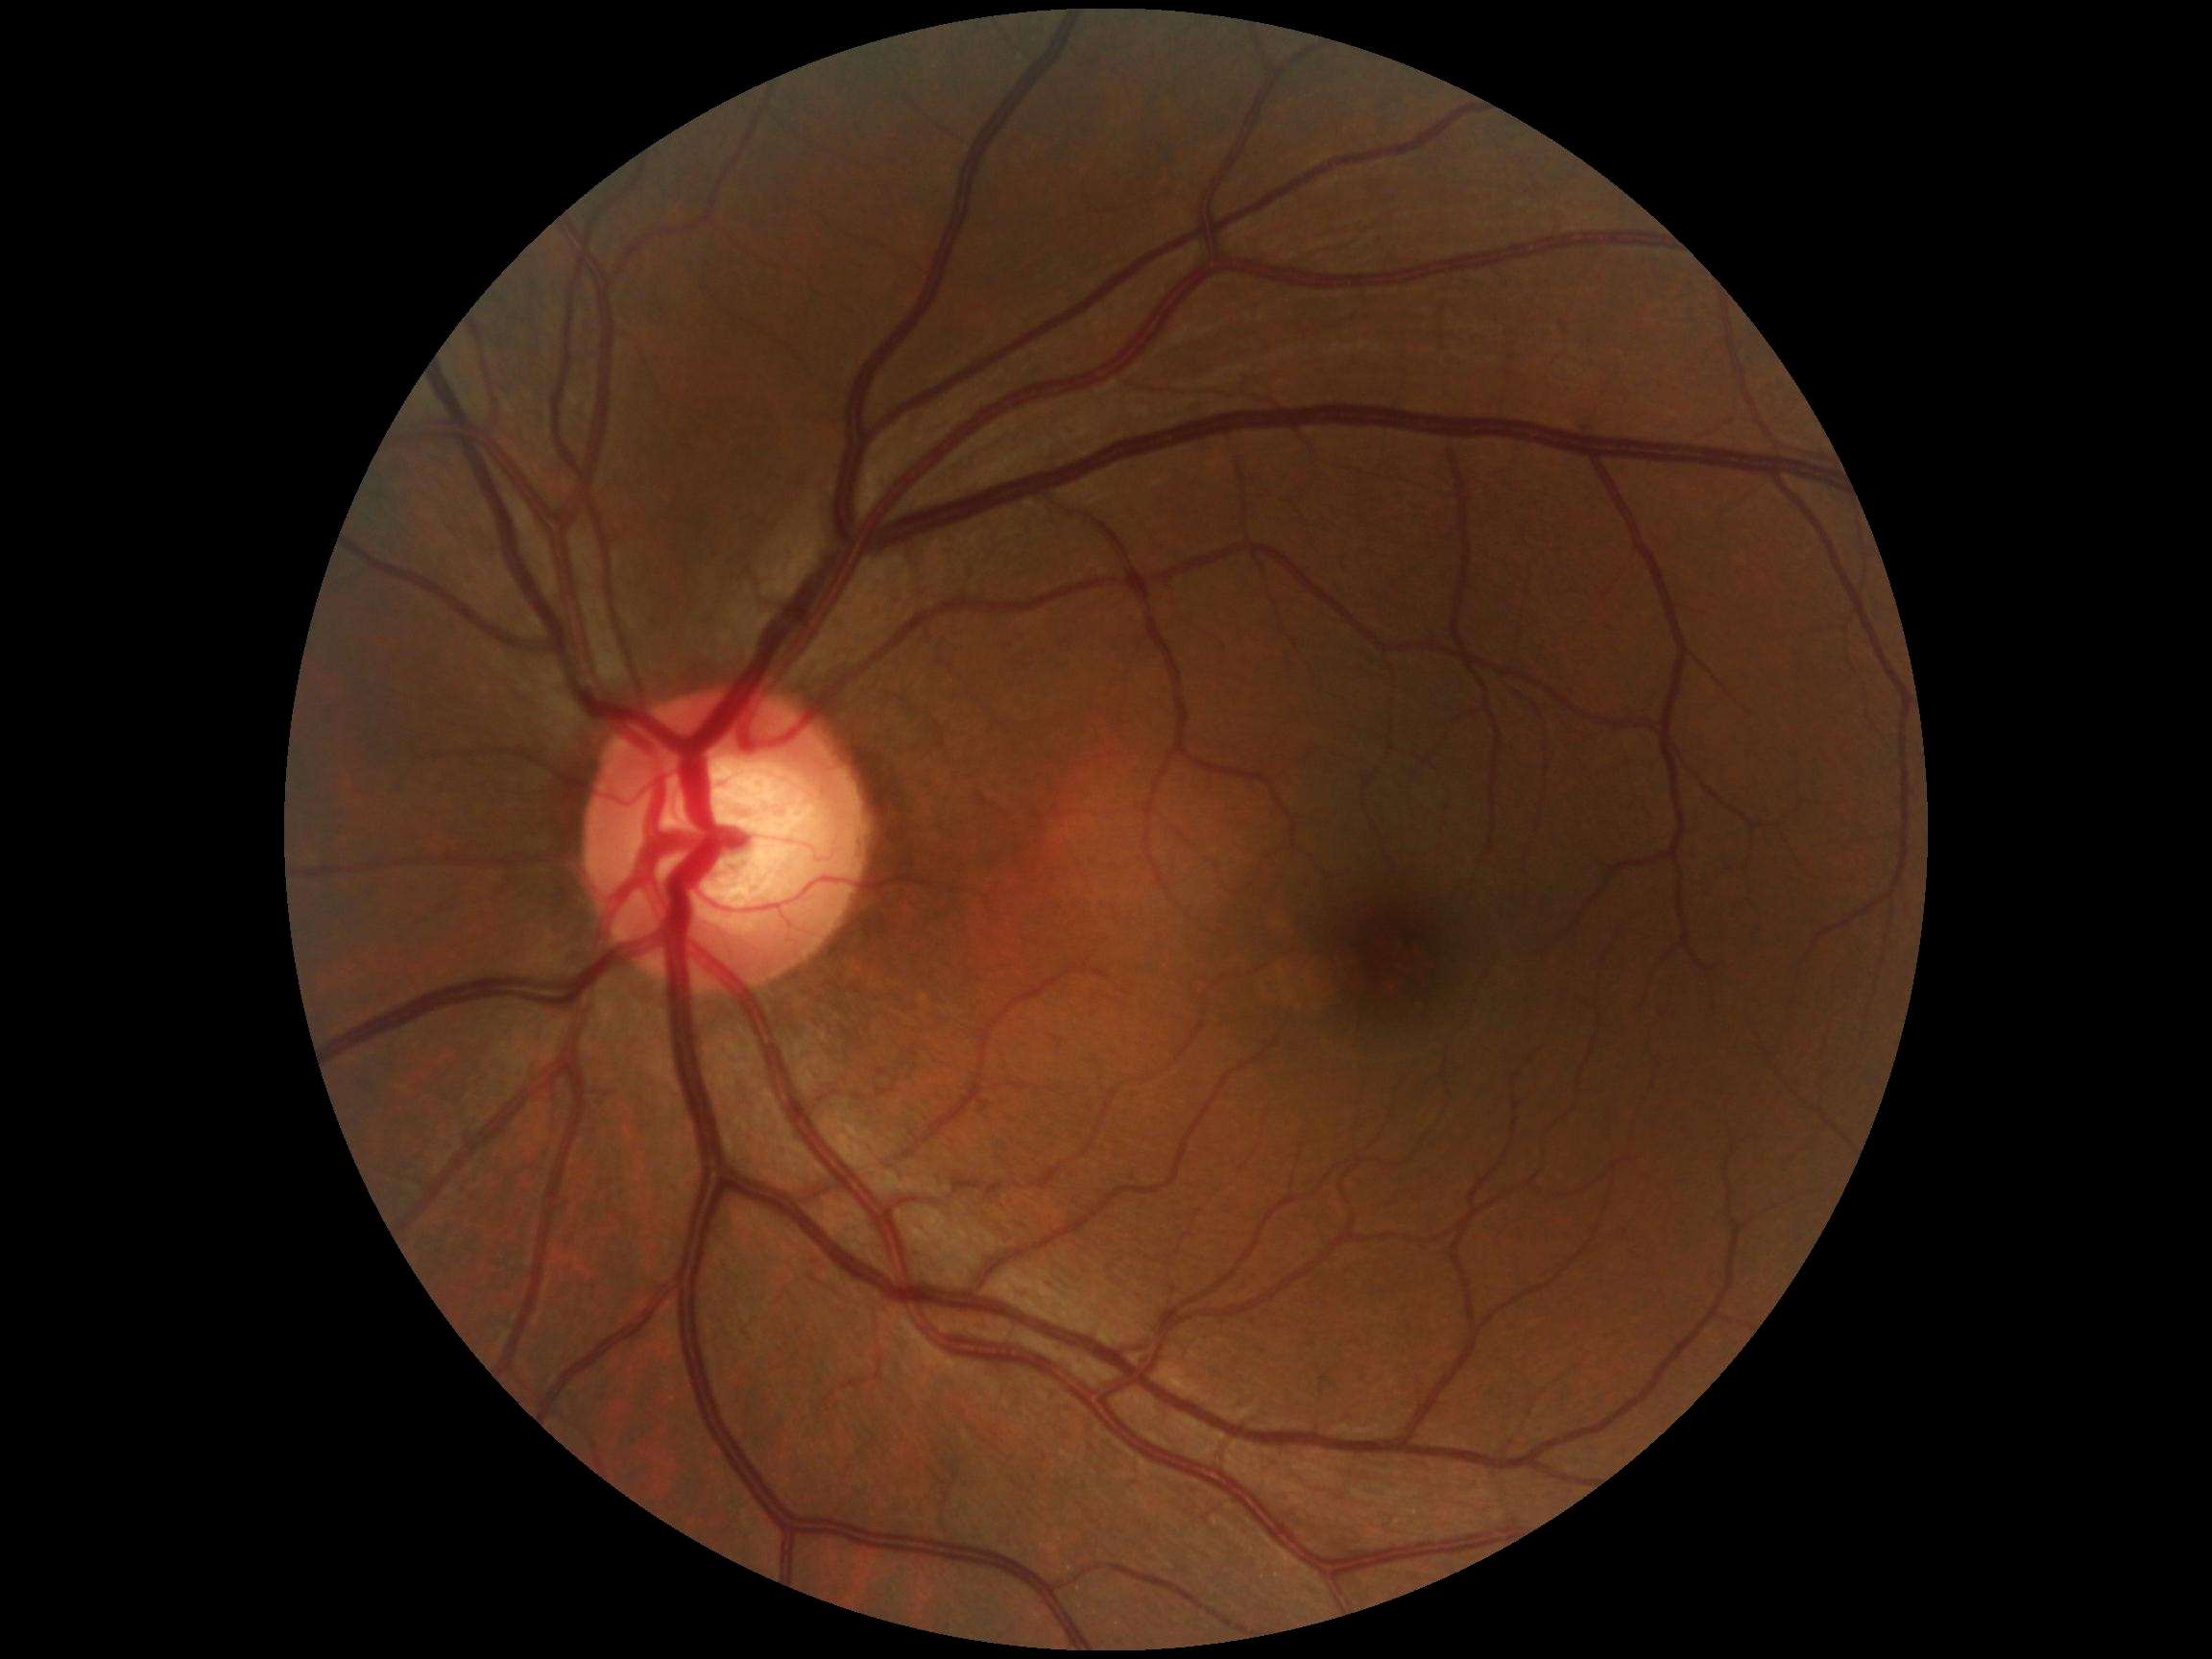
{"dr_grade": "no apparent retinopathy (grade 0)", "dr_impression": "no signs of DR"}